848x848px, 45-degree field of view — 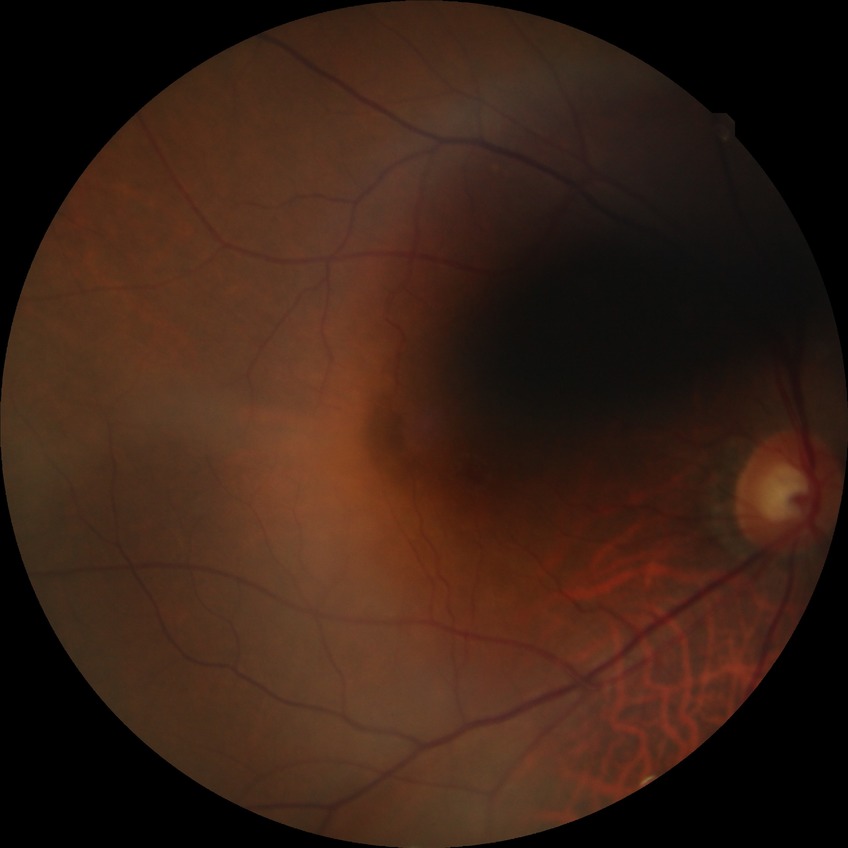 Diabetic retinopathy (DR) is no diabetic retinopathy (NDR).